CFP. 1659 by 2212 pixels:
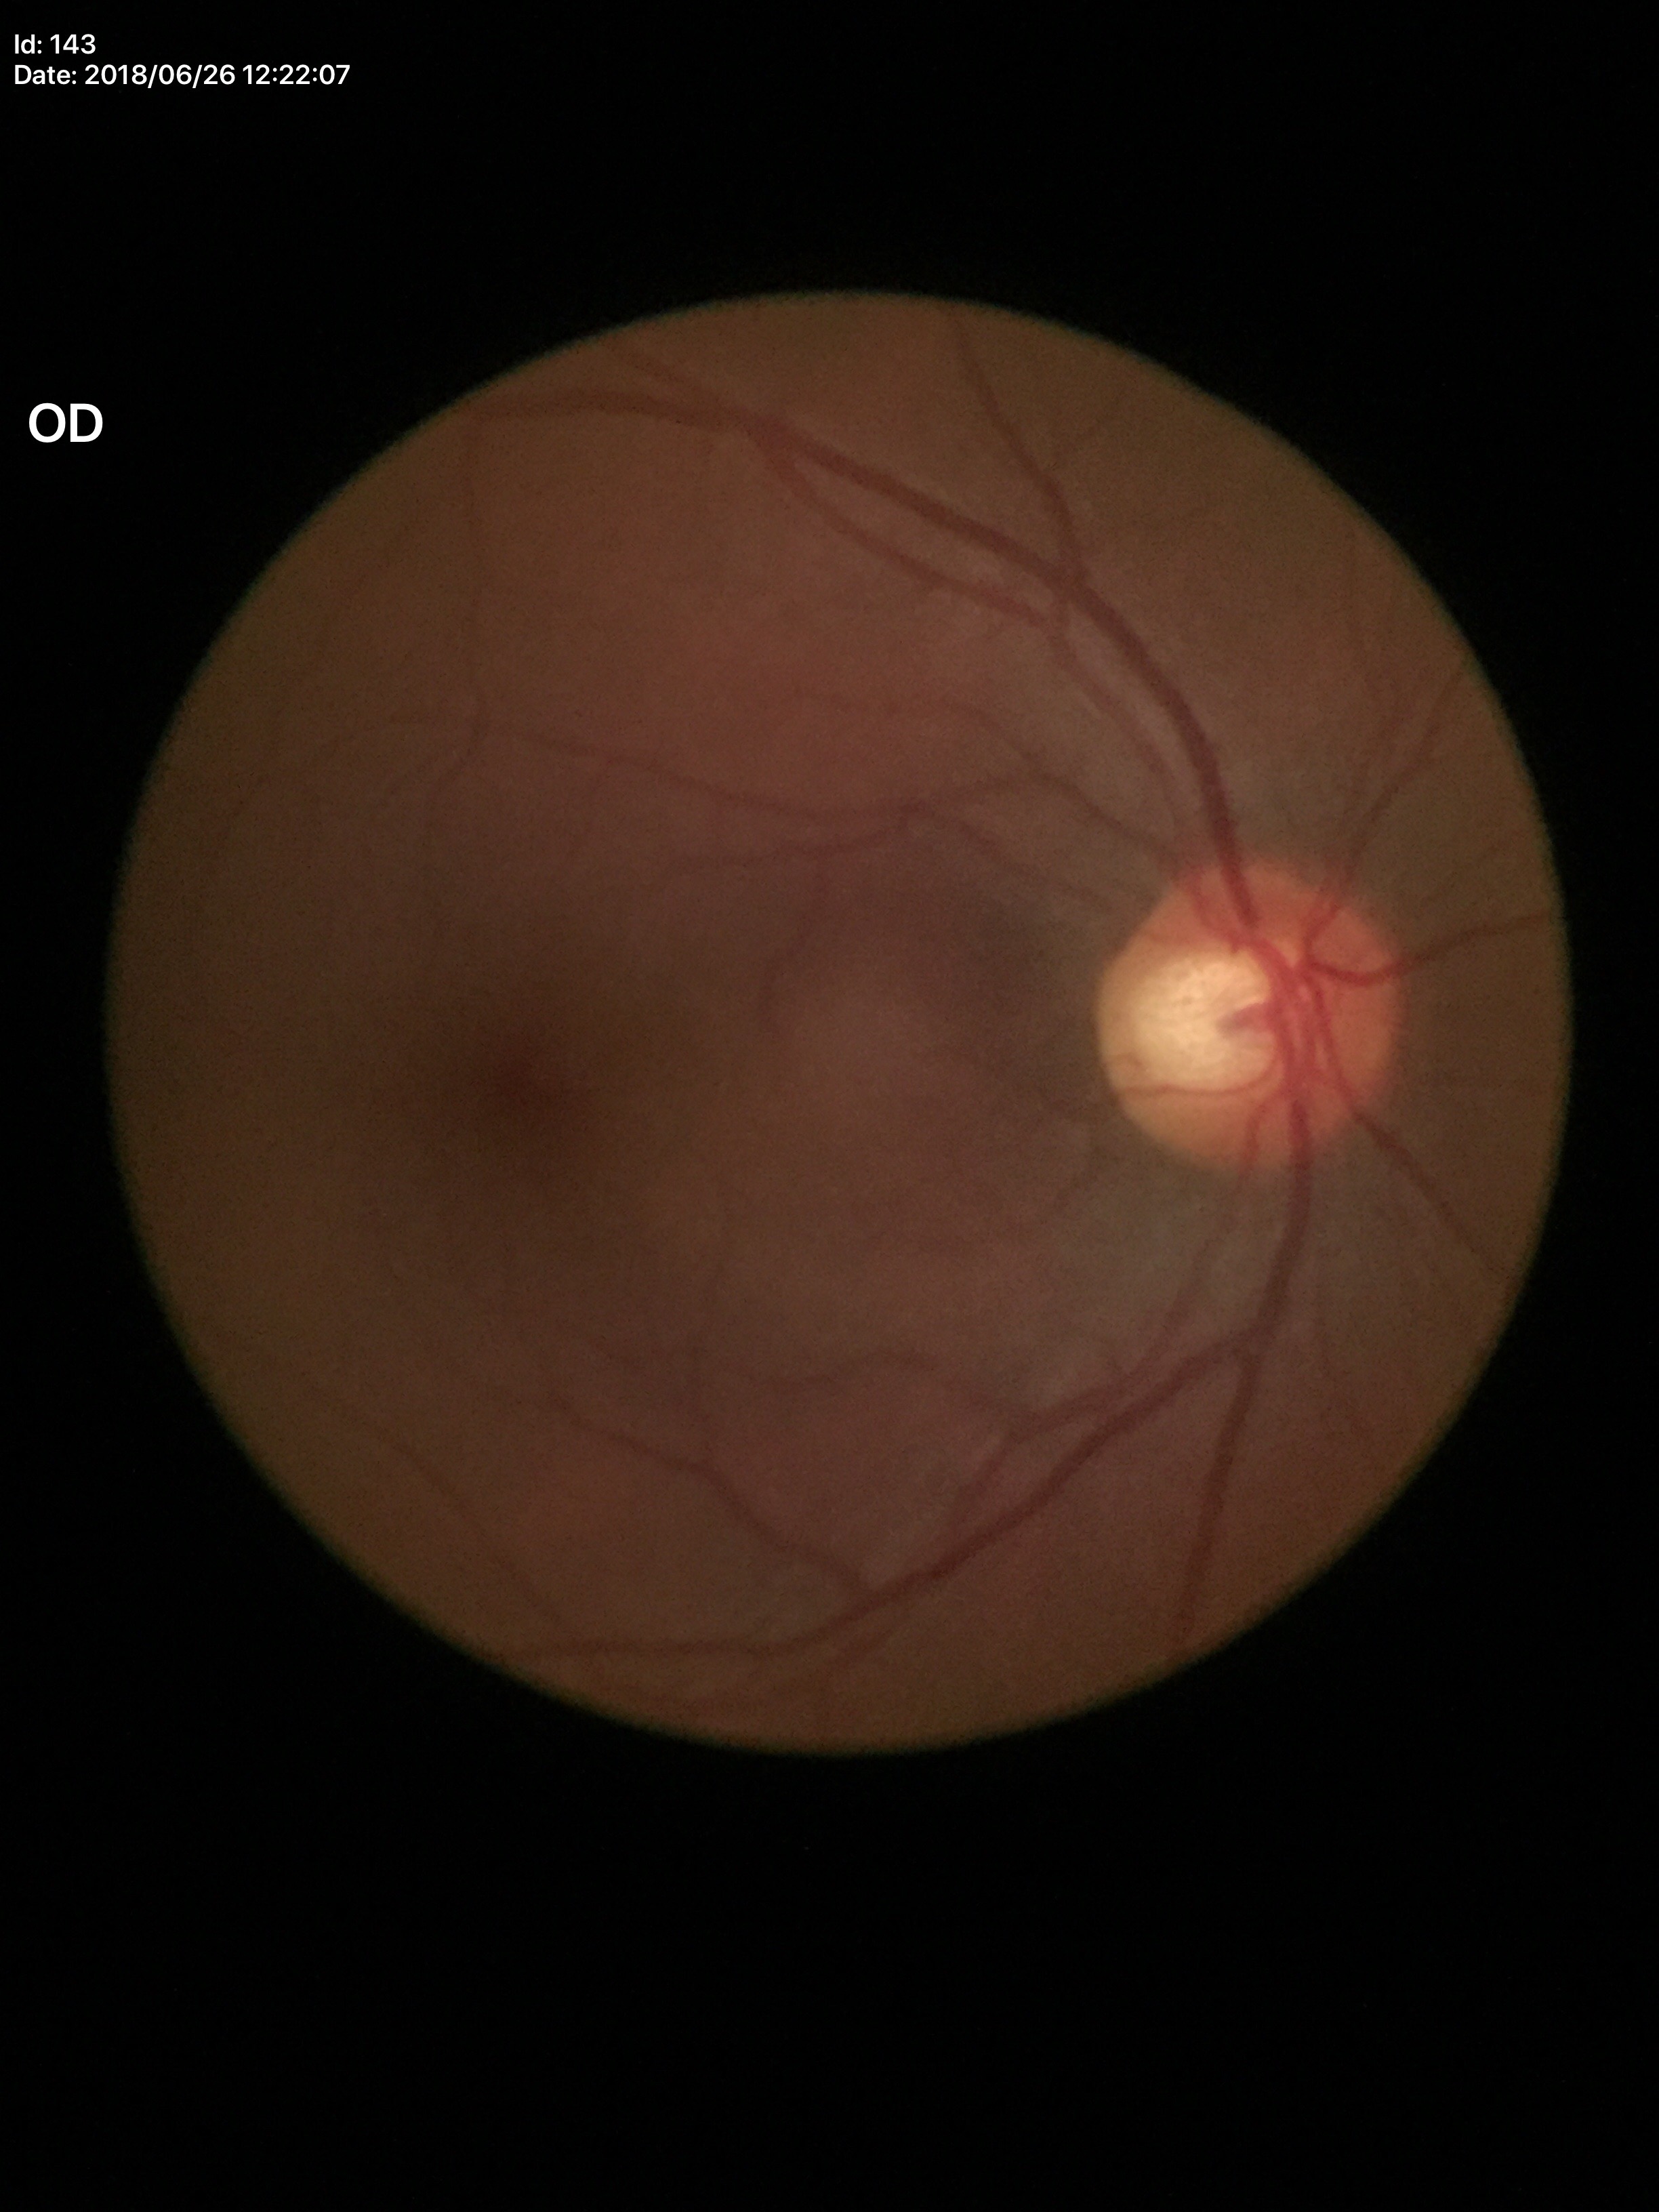 {
  "glaucoma_decision": "not suspect (2/5 graders called glaucoma suspect)",
  "vcdr": "0.60"
}